Fundus photo; 45° FOV; image size 2212x1659
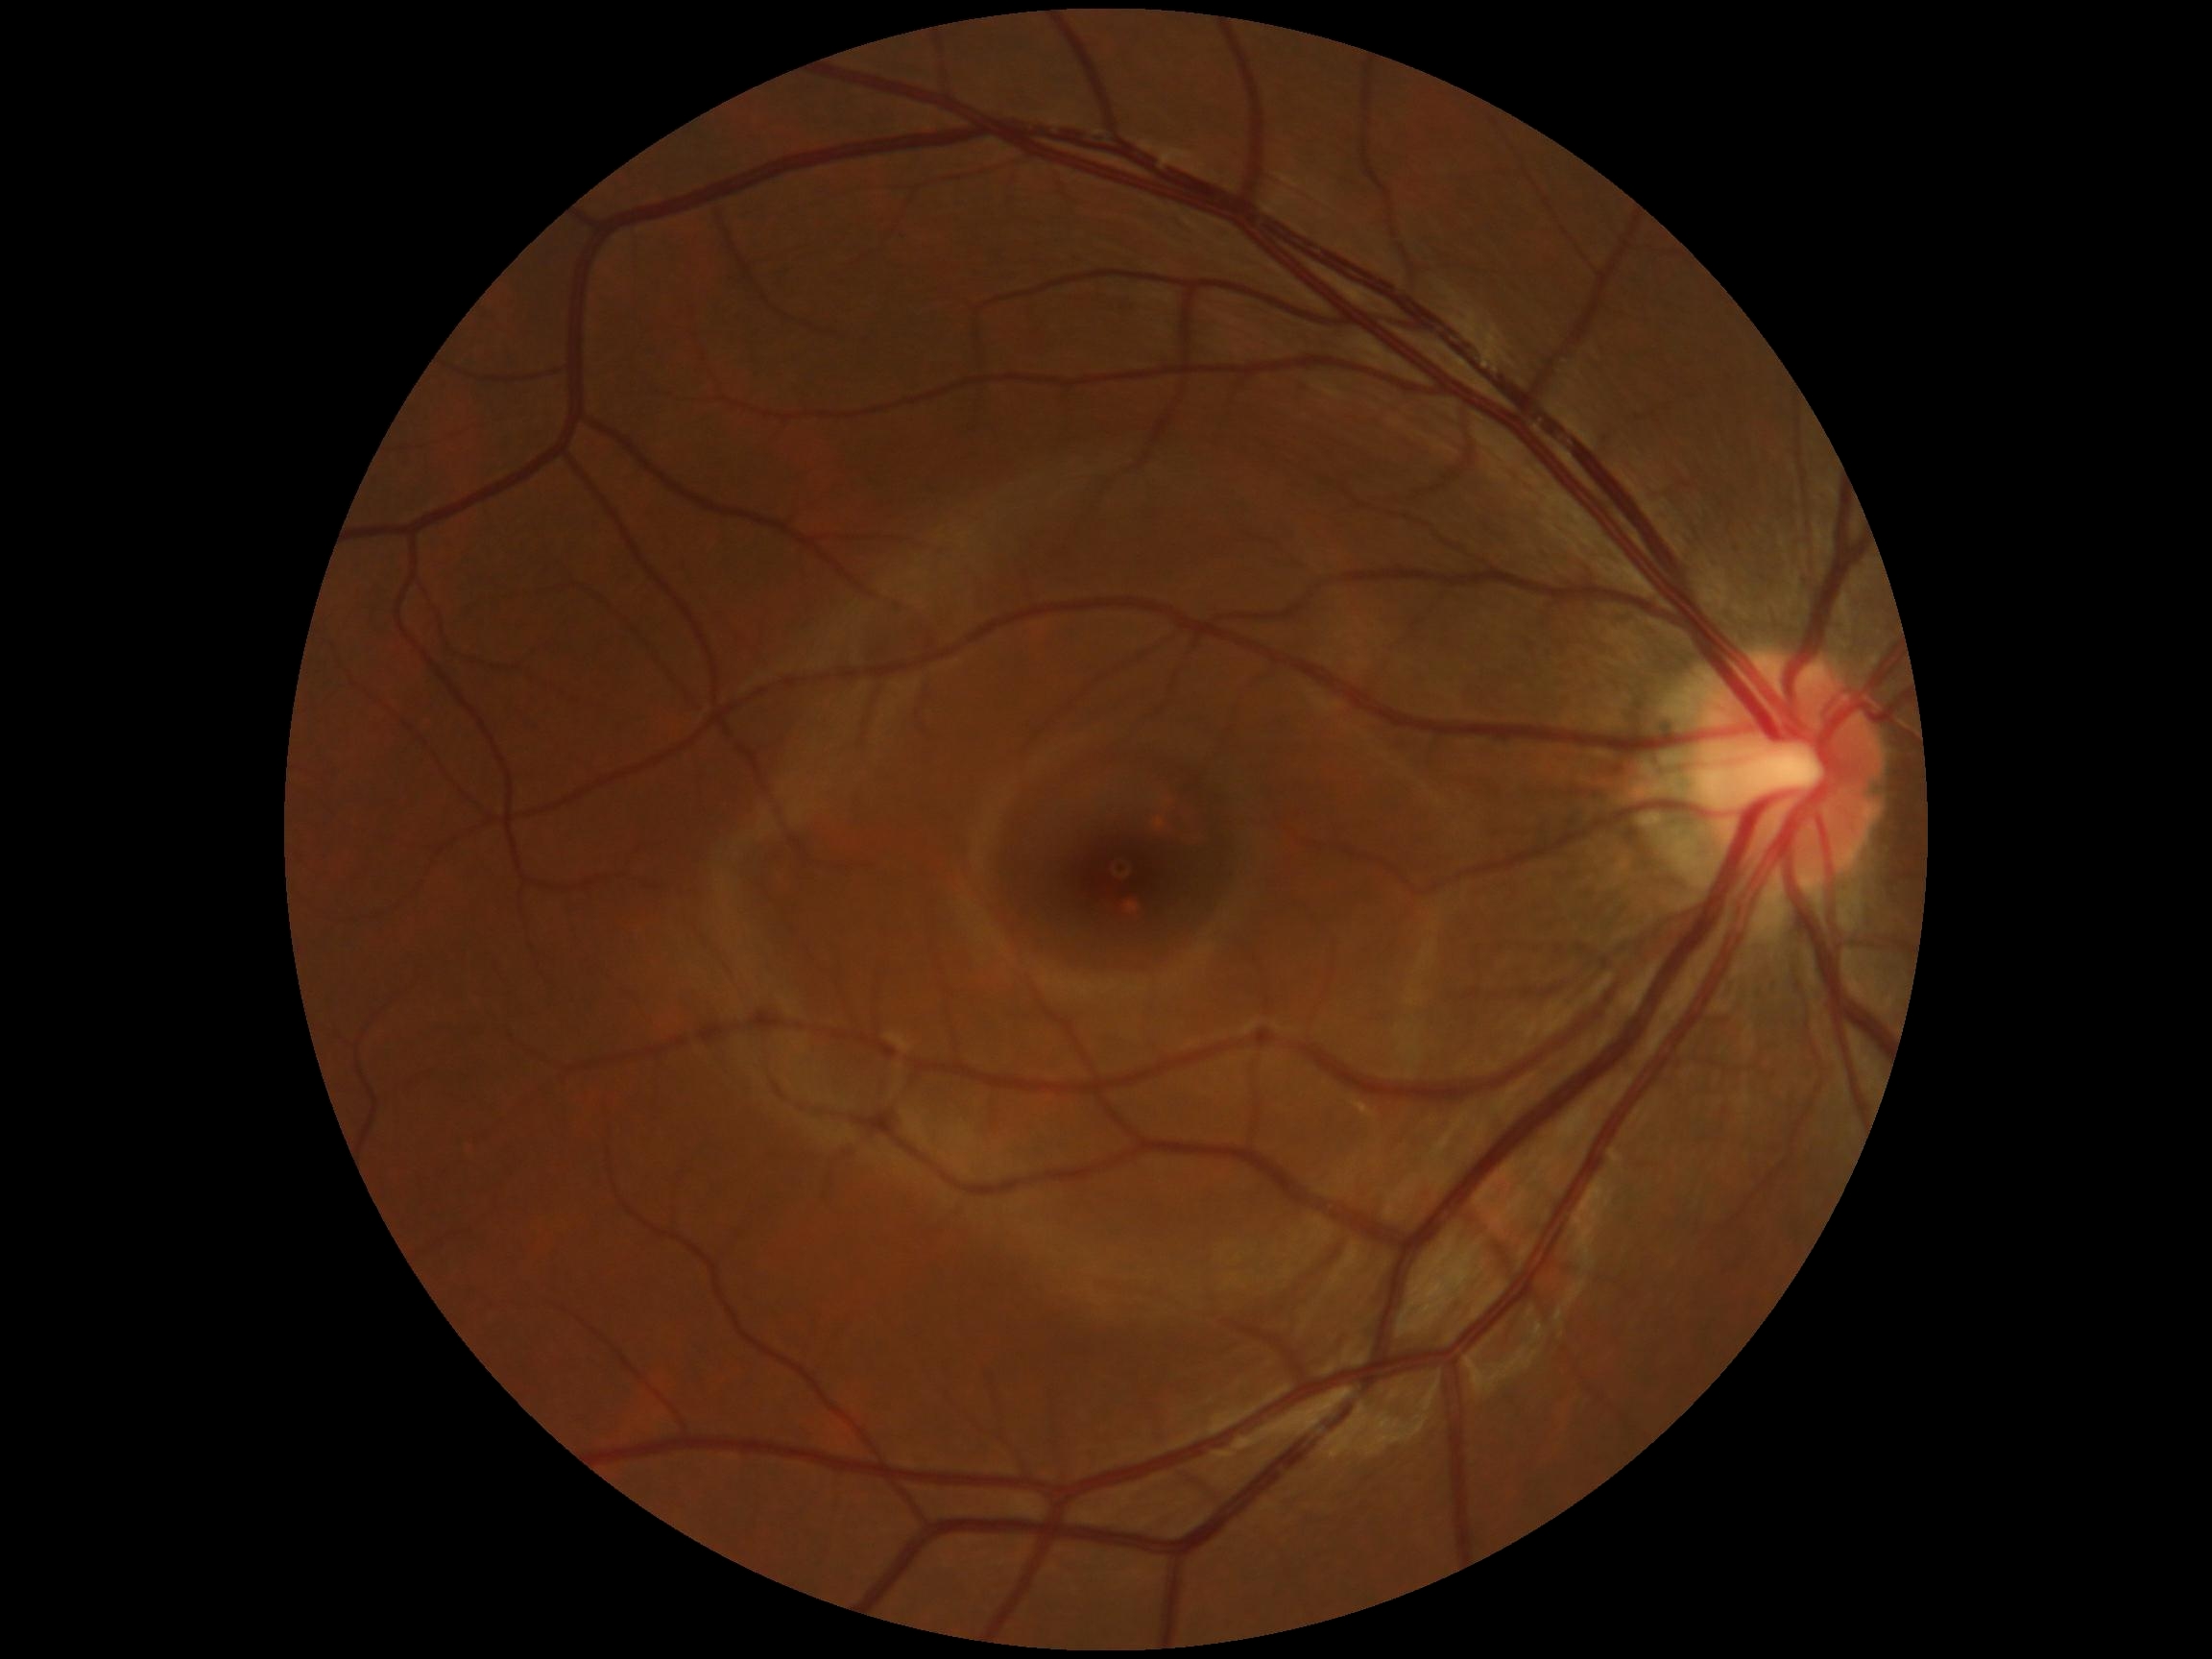

Retinopathy grade is 0/4.